Color fundus image
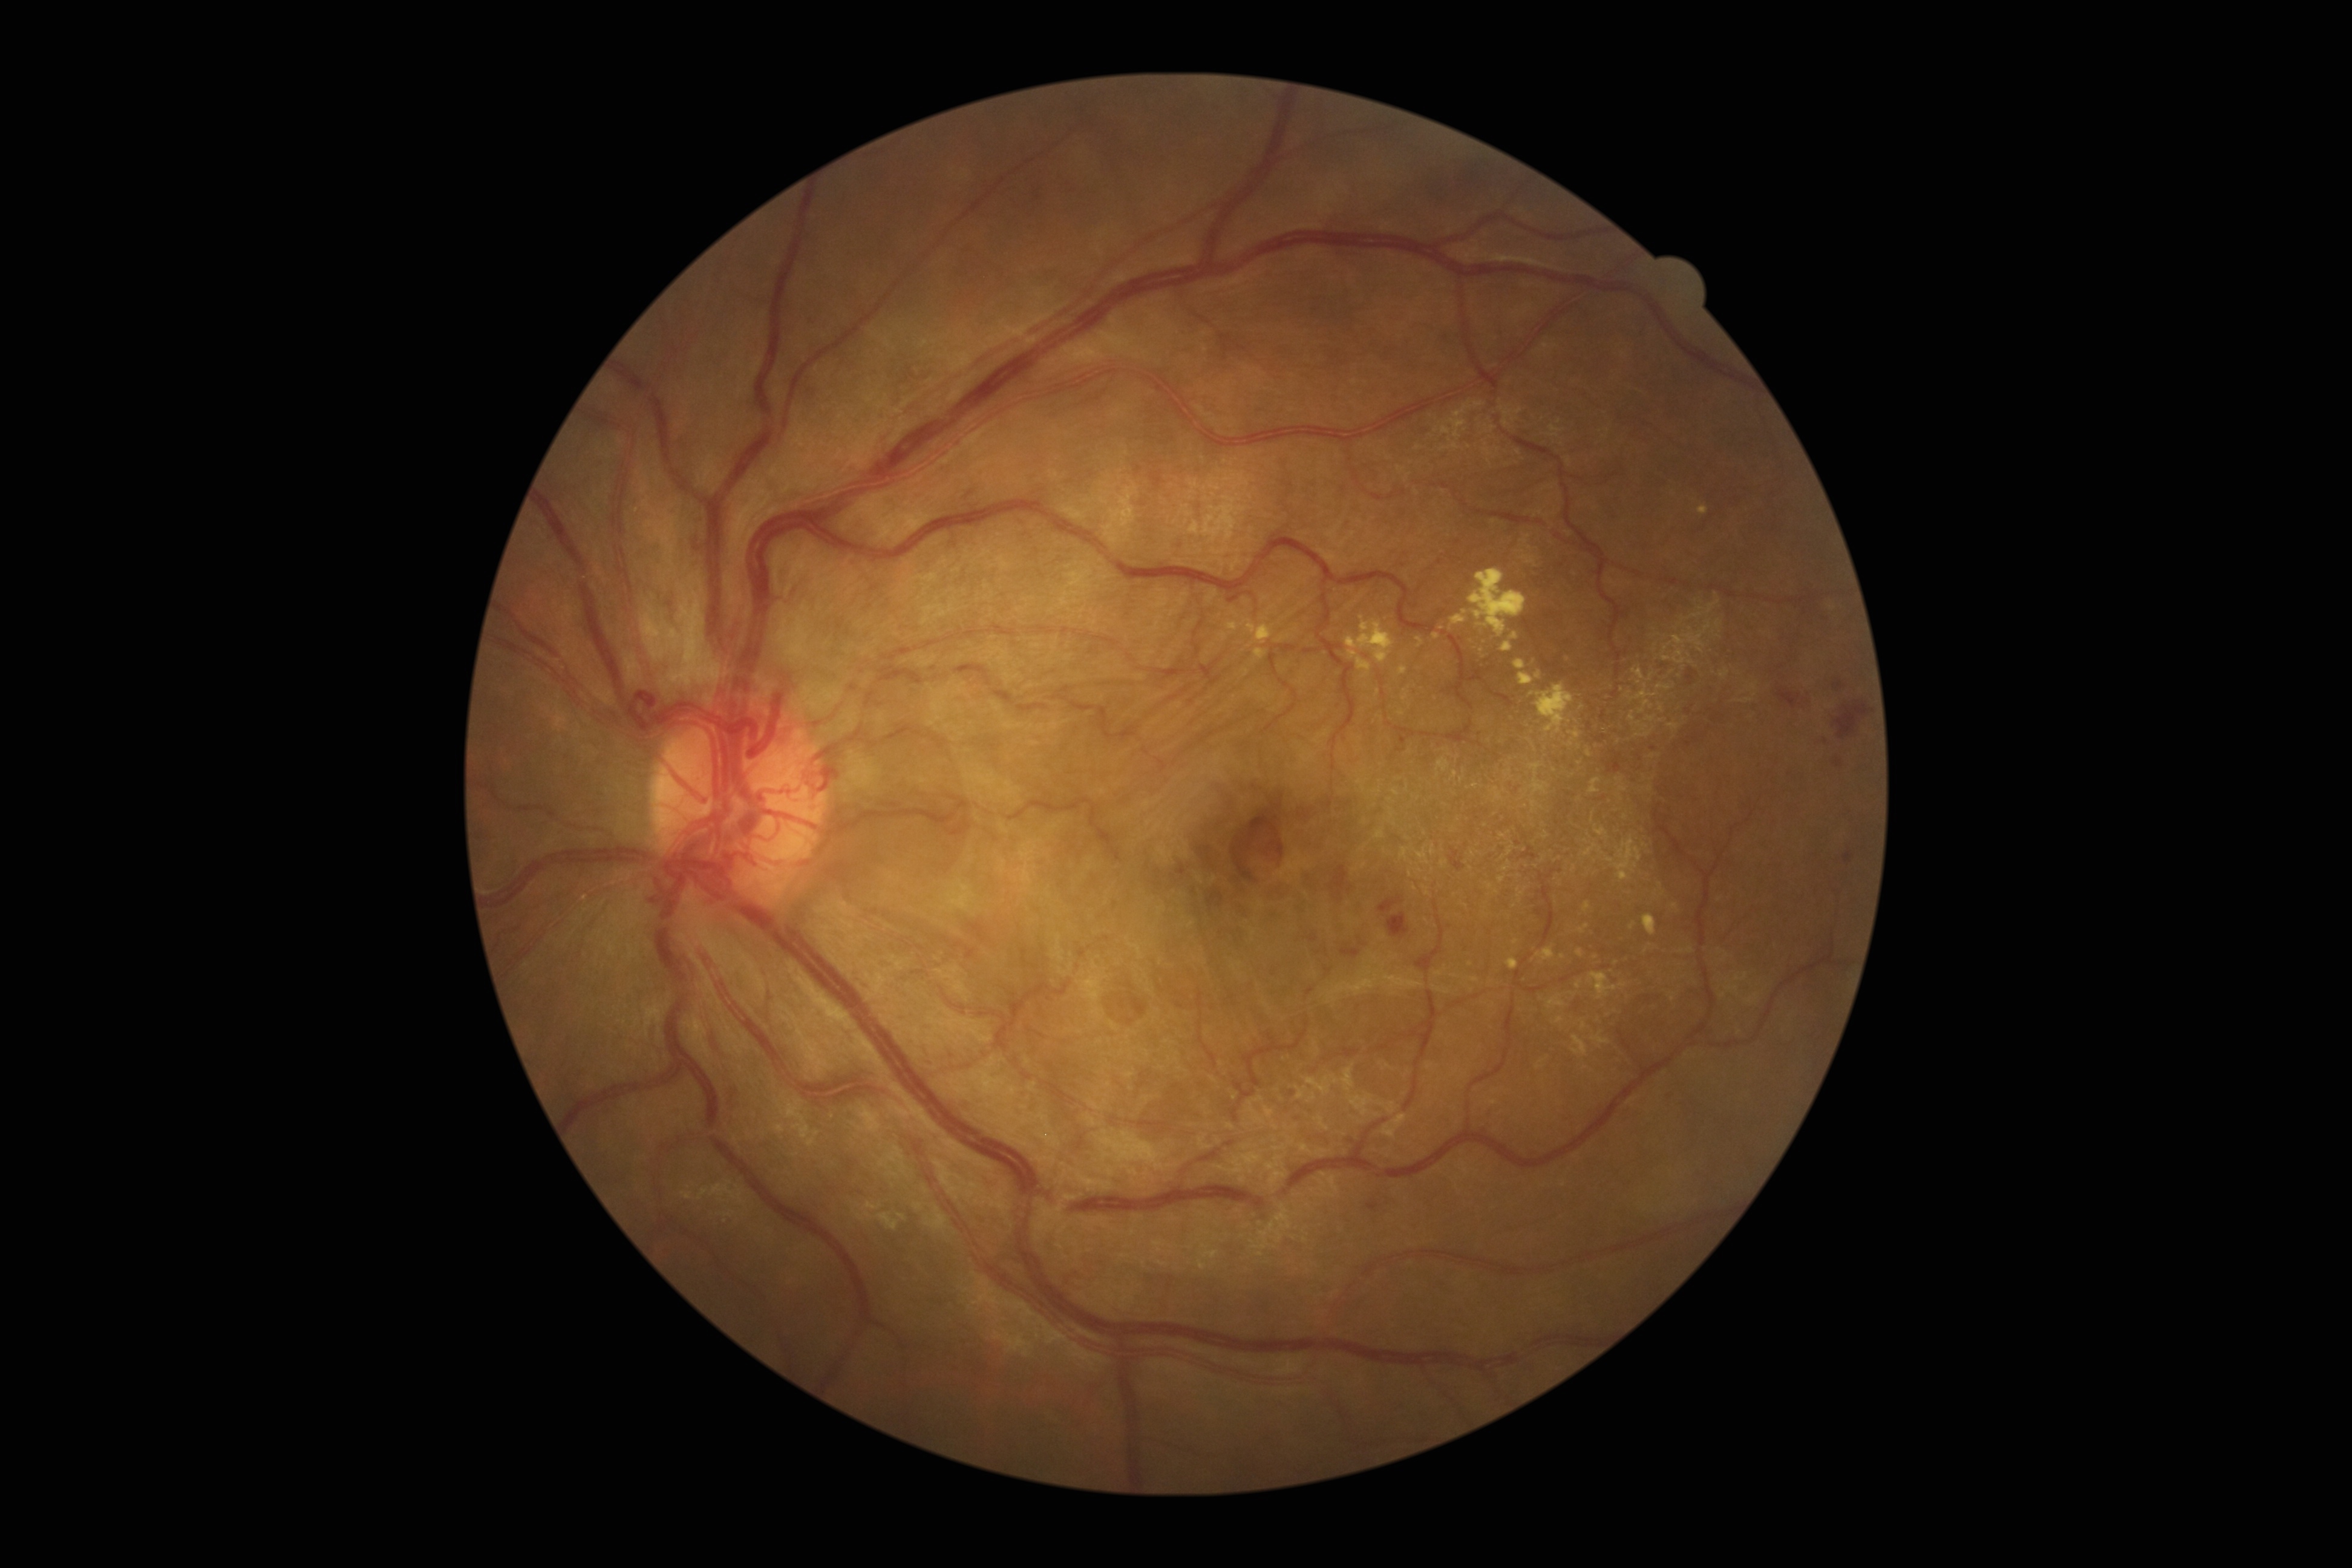 <lesions partial="true">
  <dr_grade>4</dr_grade>
  <ex partial="true">1577/949/1584/958 | 1642/914/1657/936 | 1417/637/1425/648 | 1432/632/1440/639 | 1254/648/1267/659 | 1587/748/1593/757 | 1506/958/1519/970 | 1519/673/1534/685 | 1570/729/1581/739 | 1241/620/1275/648 | 1226/621/1240/631 | 1346/616/1396/679 | 1577/924/1589/933 | 1567/740/1575/747</ex>
  <ex_small_approx>1441/628 | 1563/957 | 1632/926 | 1579/763 | 1465/612 | 1516/941</ex_small_approx>
</lesions>